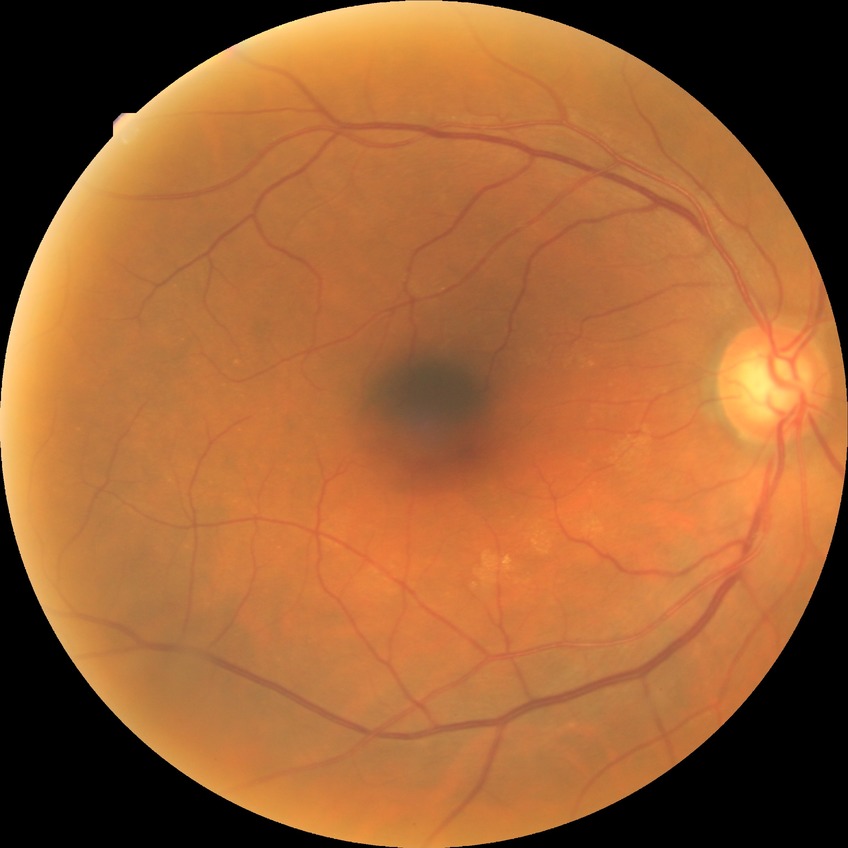

DR grade is NDR.